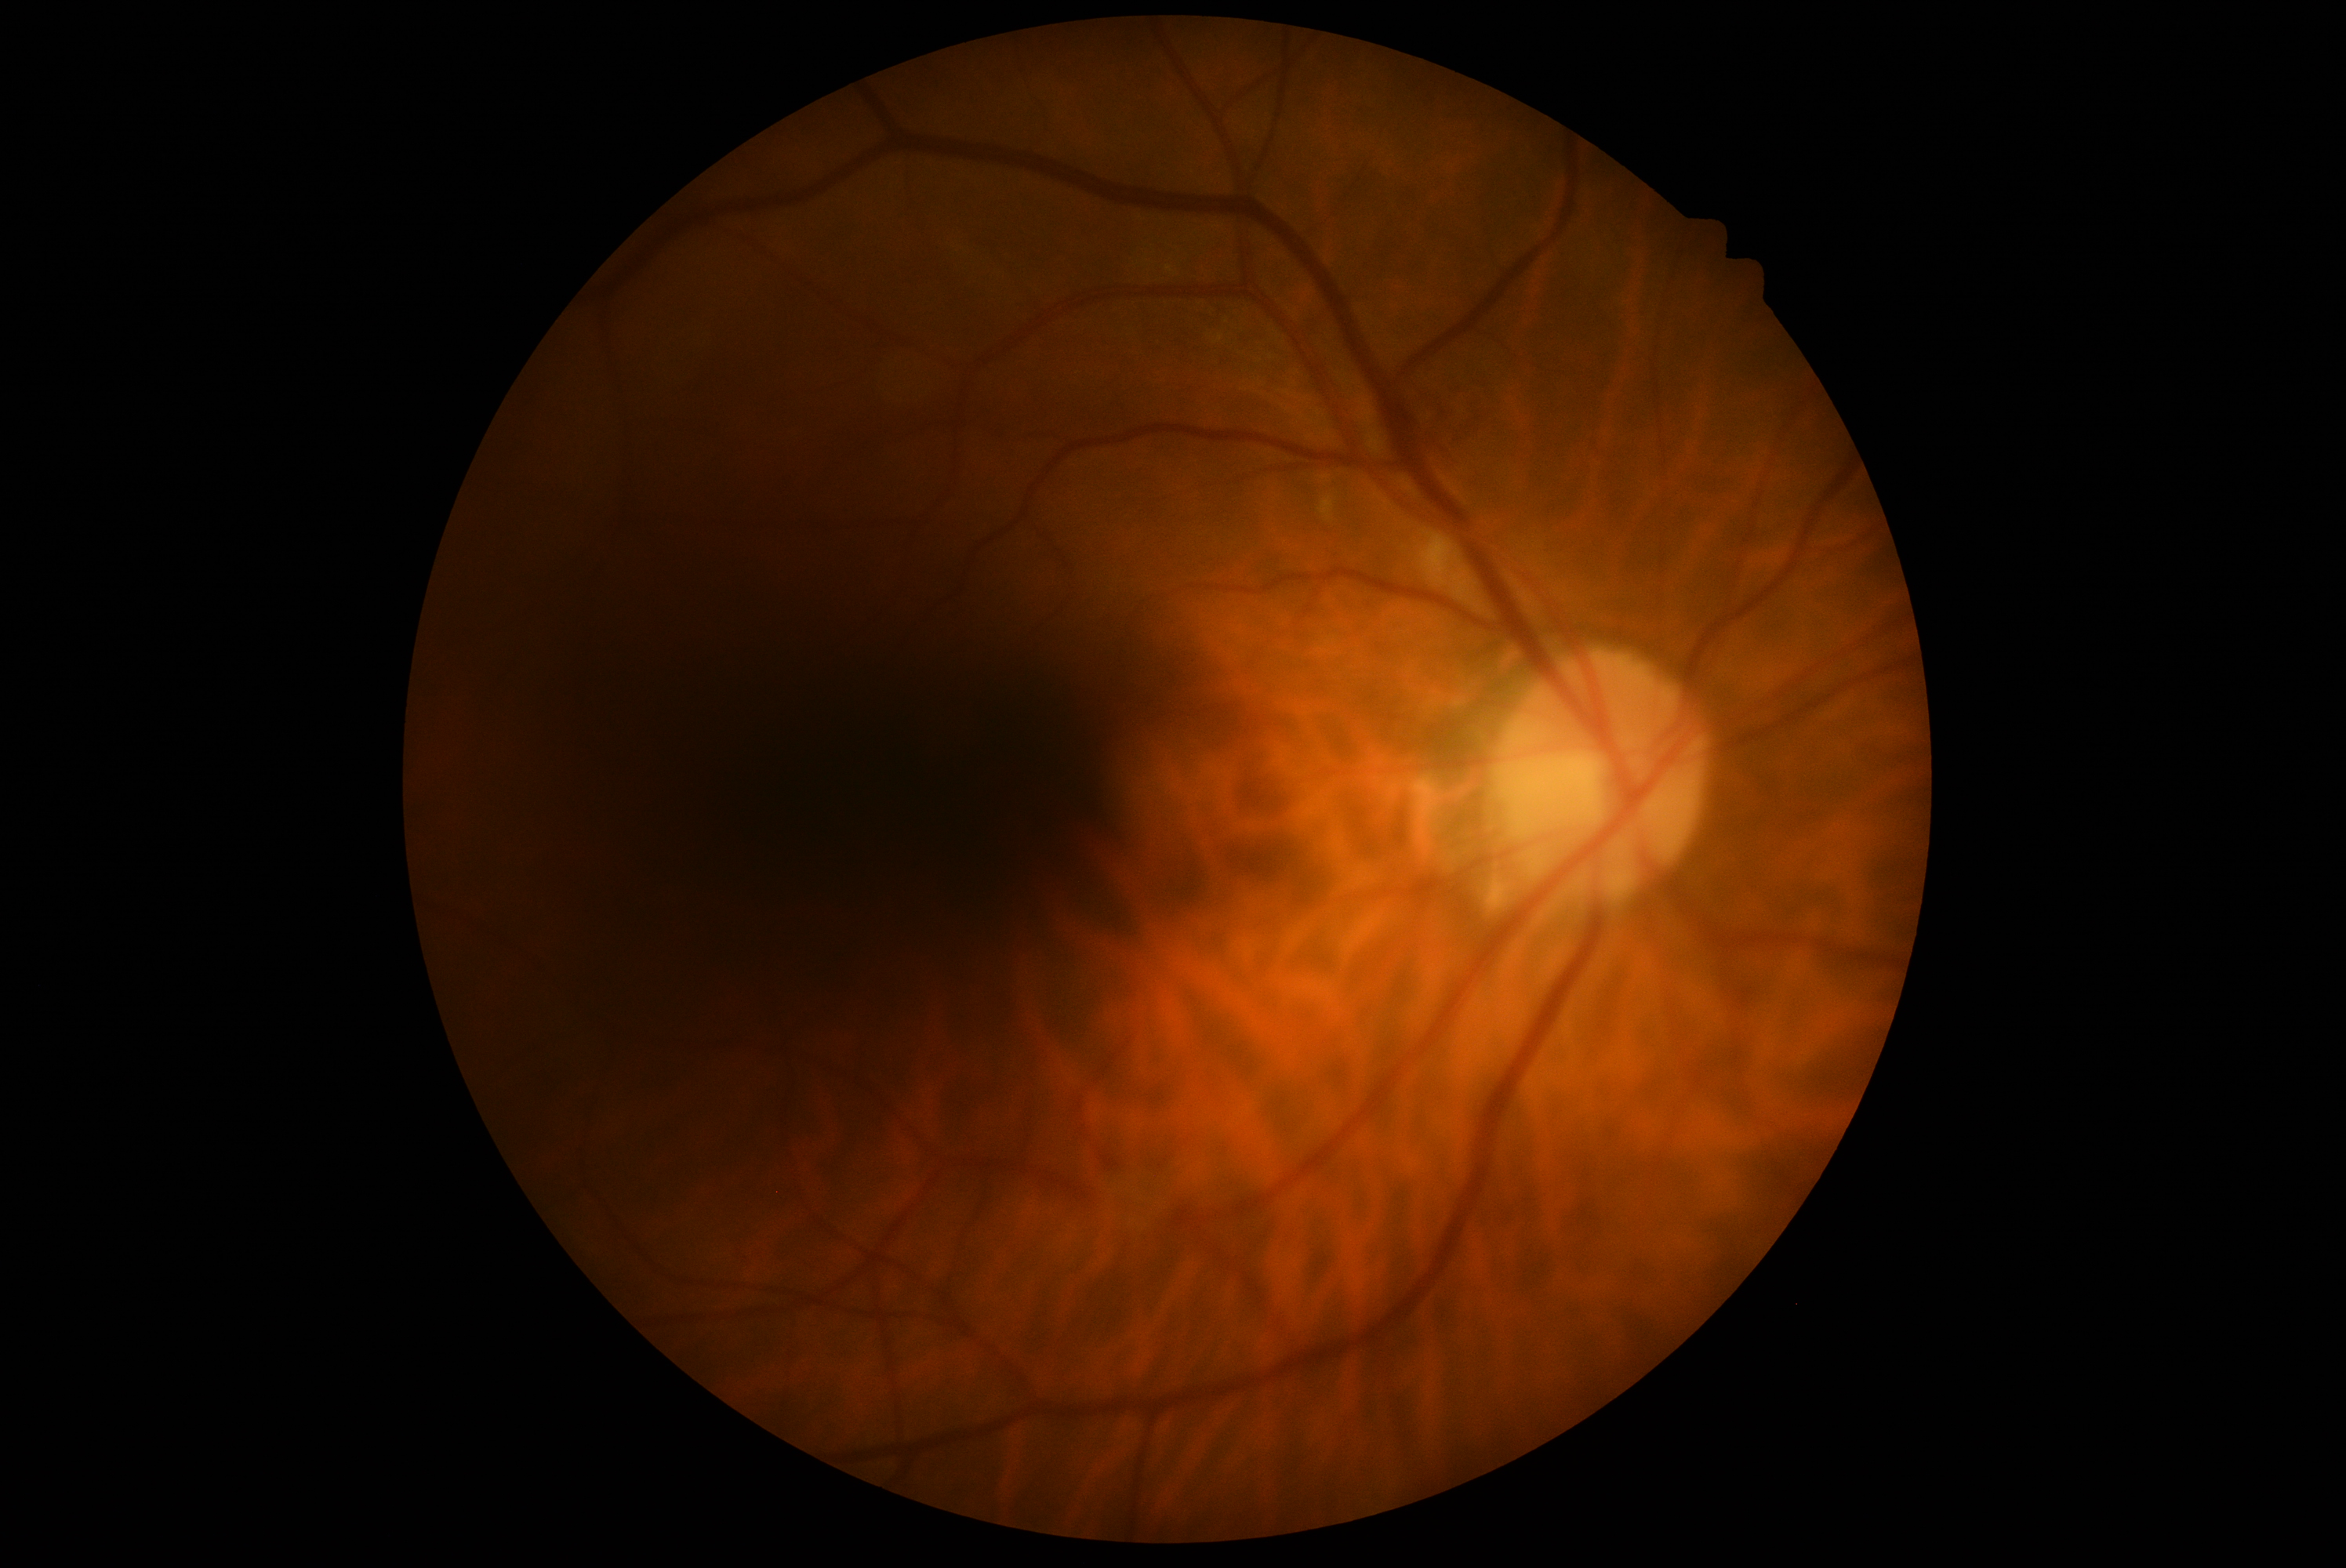
Diabetic retinopathy severity is moderate NPDR (grade 2).